45-degree field of view · color fundus image — 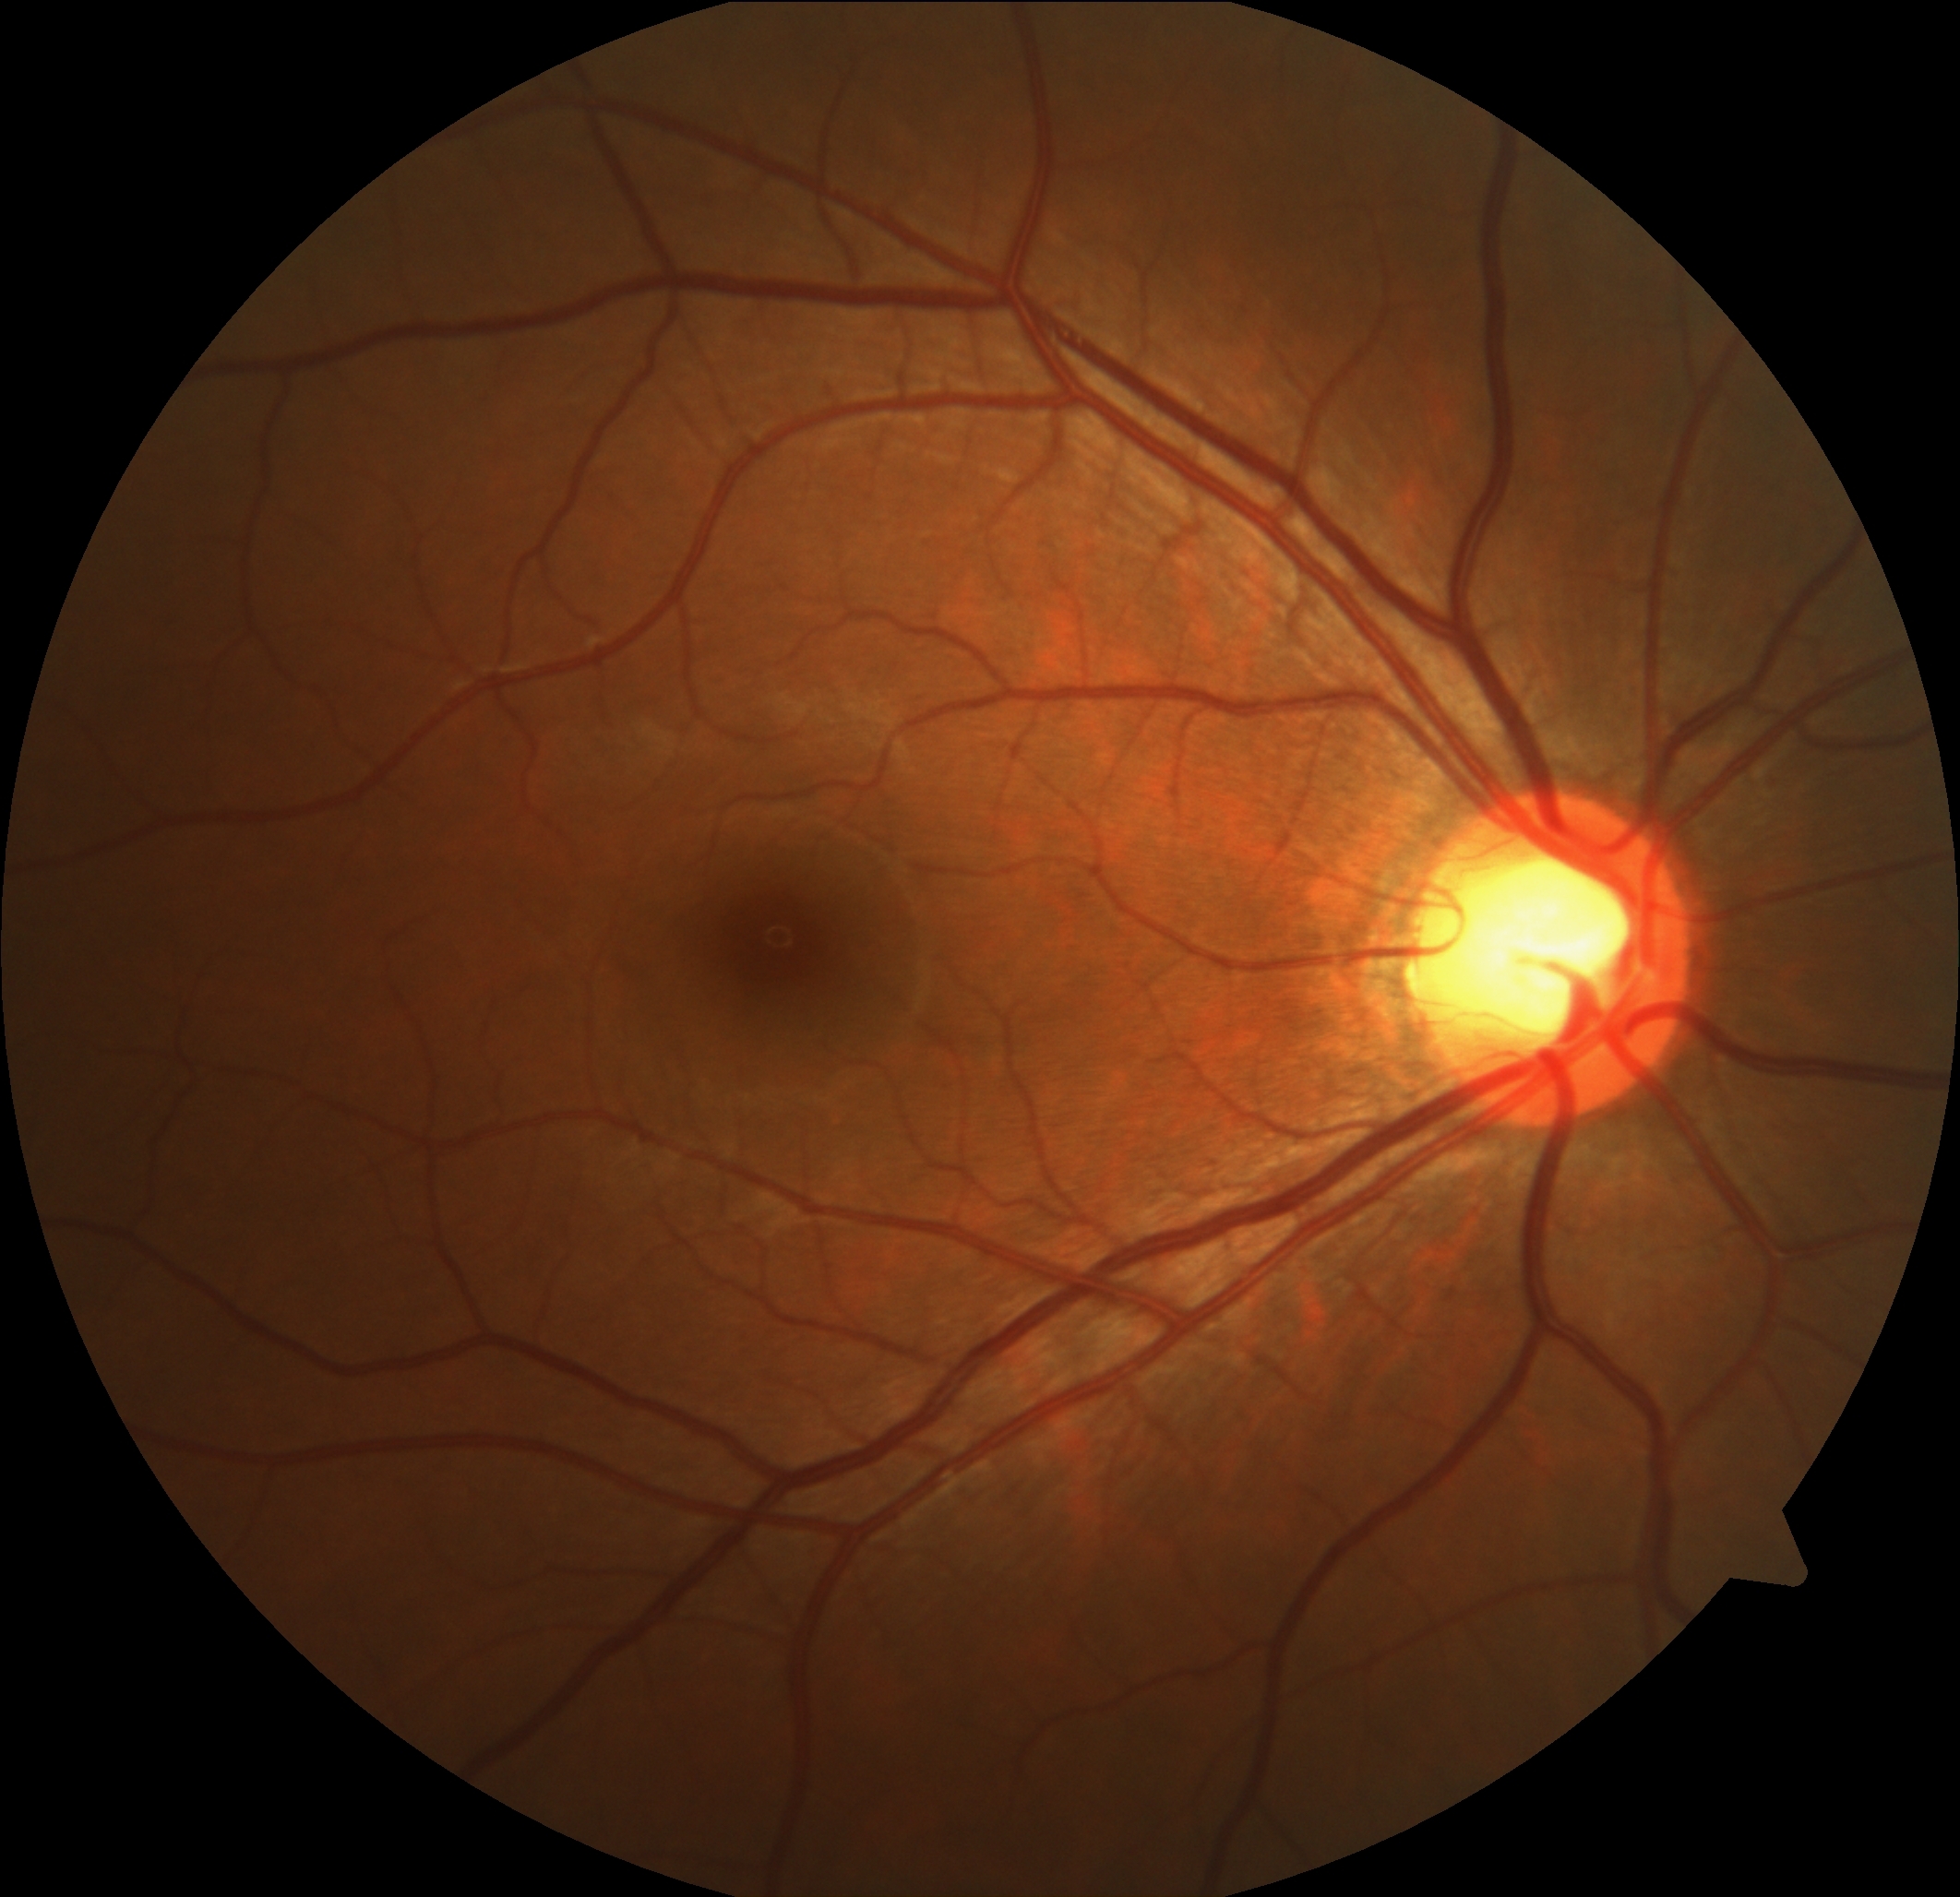 DR grade: 0/4.